45° field of view. 1932 x 1910 pixels: 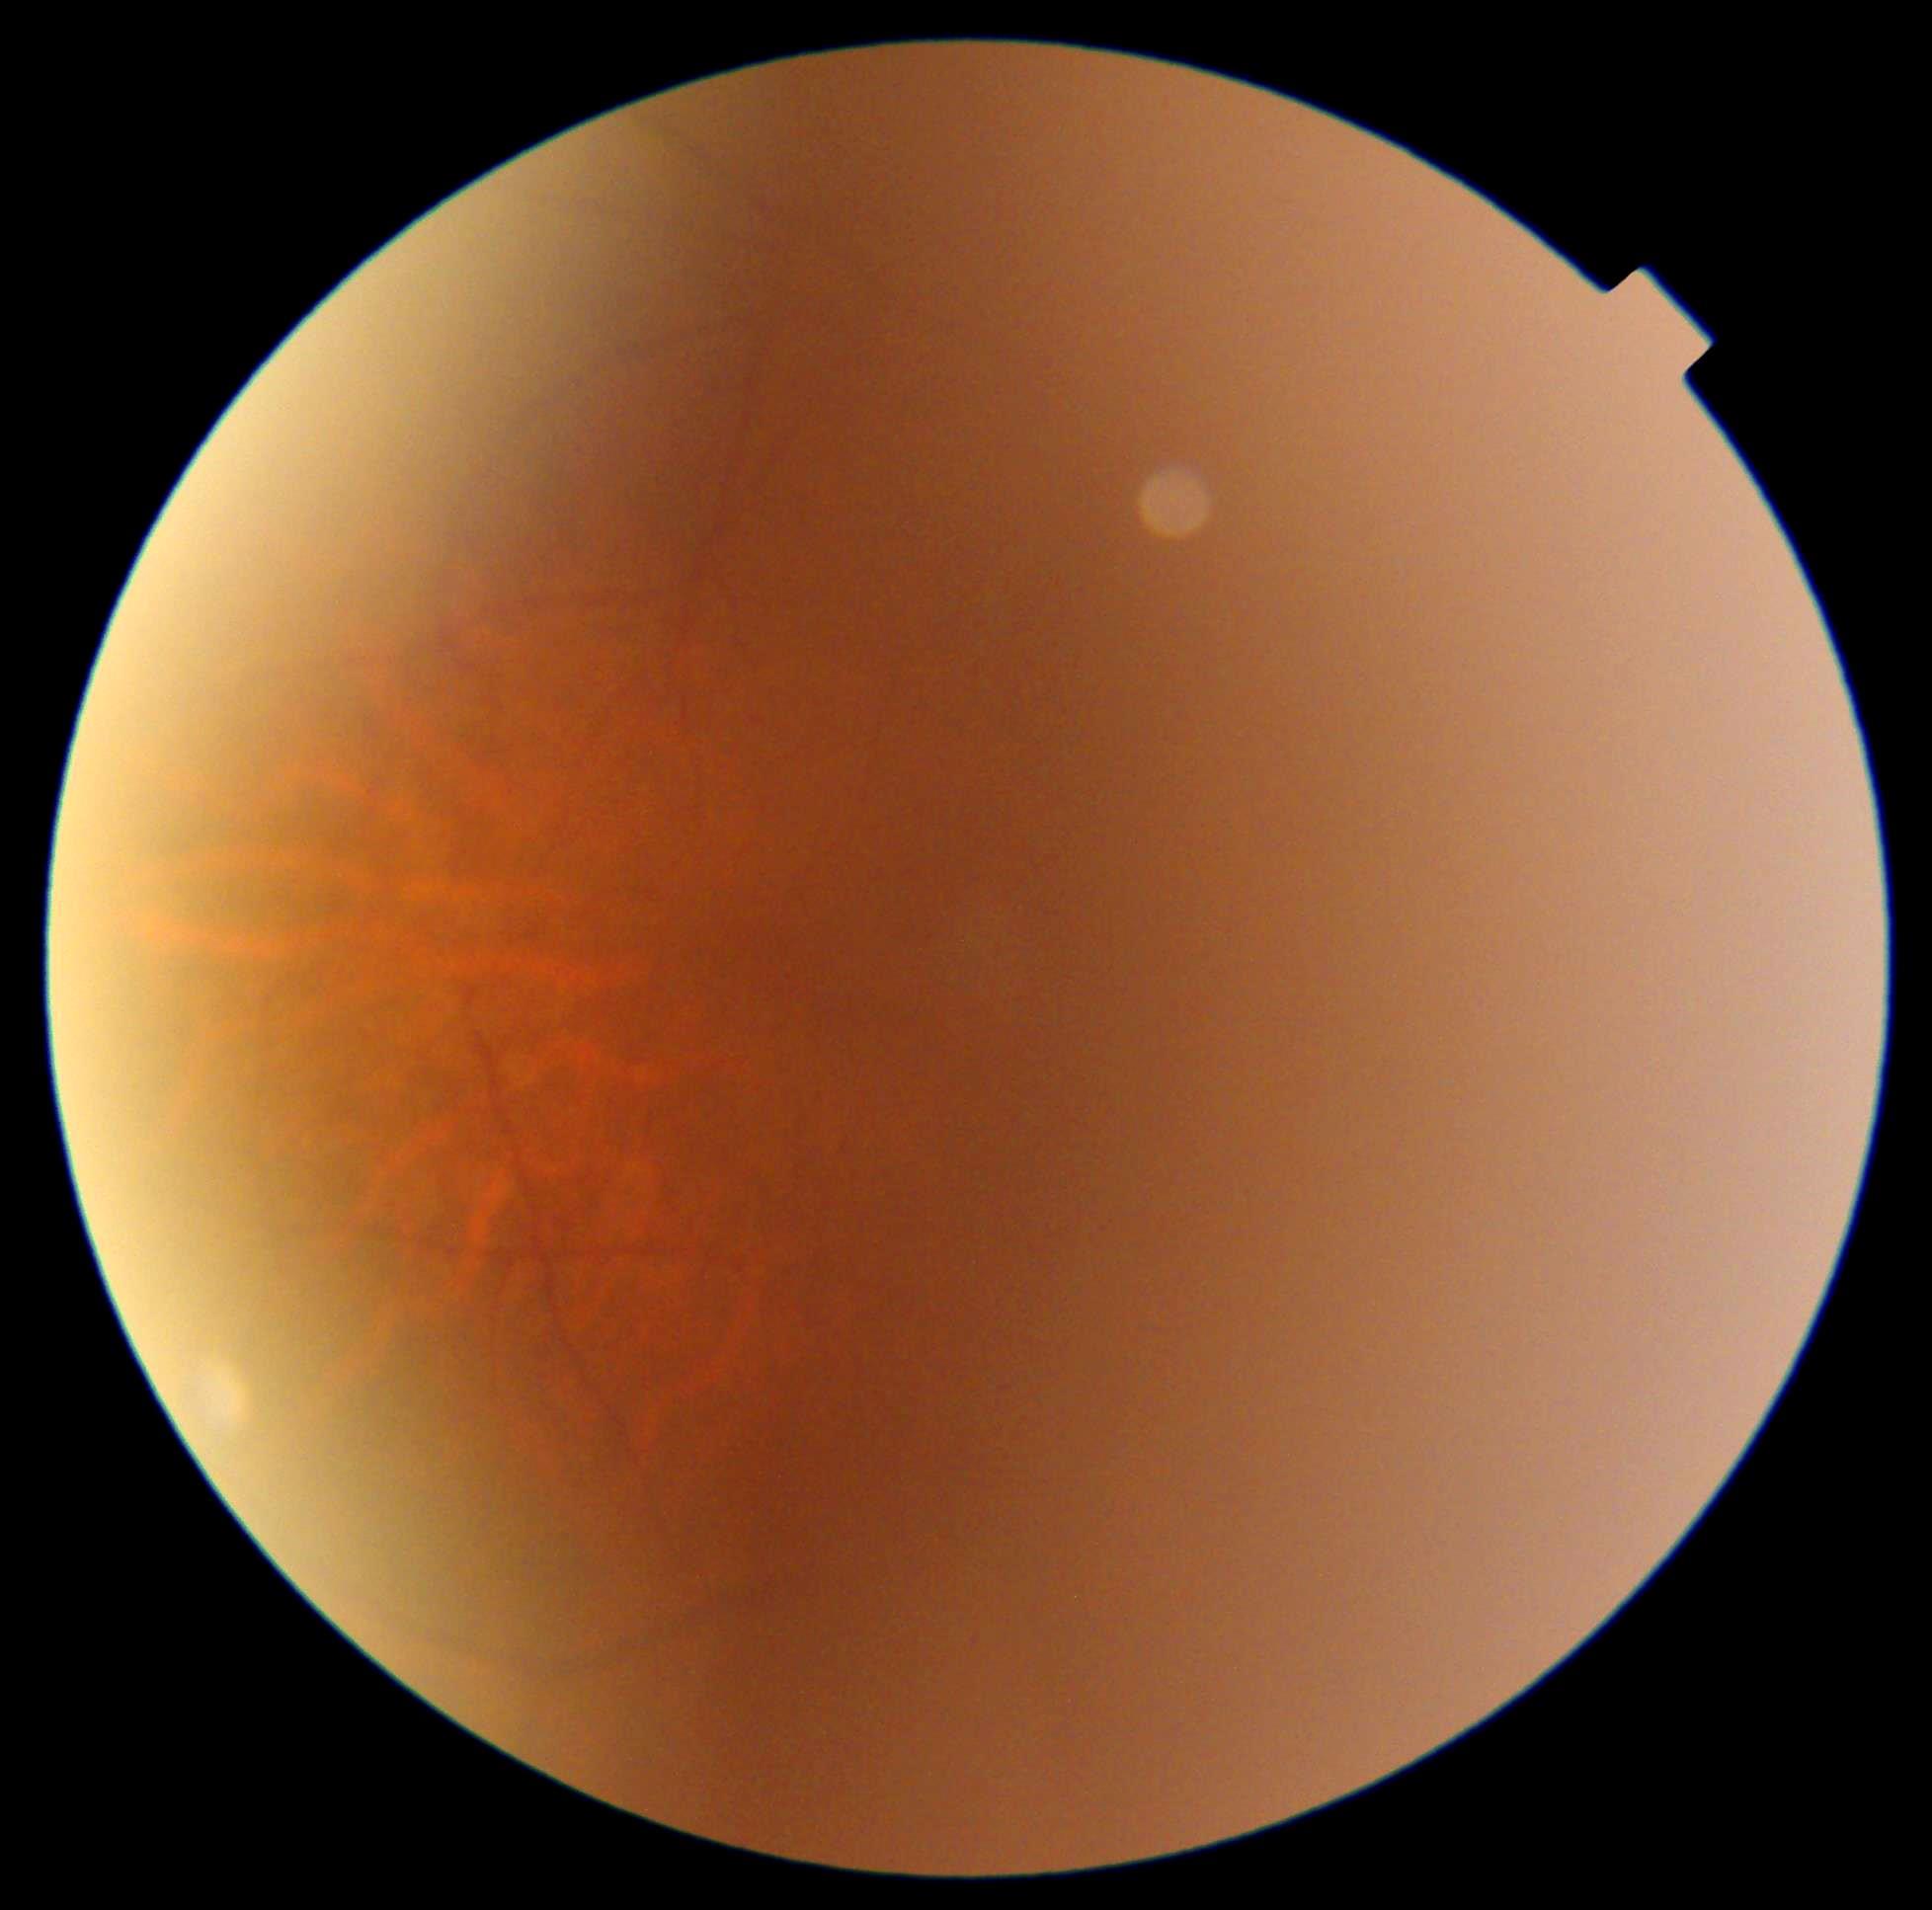

Ungradable image — DR severity cannot be determined. Diabetic retinopathy (DR) is ungradable.